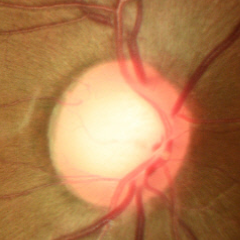

Q: Glaucoma assessment?
A: No — no signs of glaucoma.